512 by 512 pixels; fundus photo:
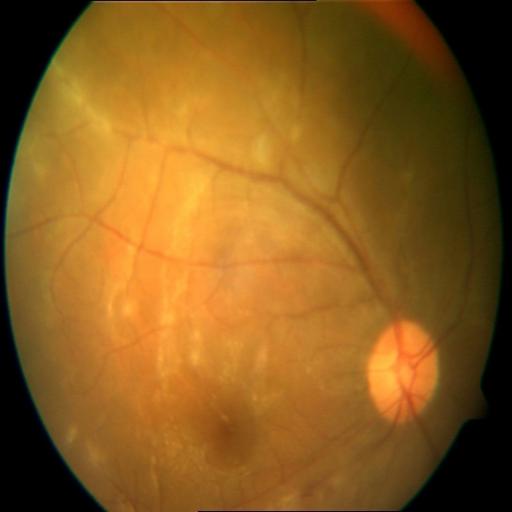 Diagnosis:
- EDN (exudation)